45° FOV; color fundus photograph:
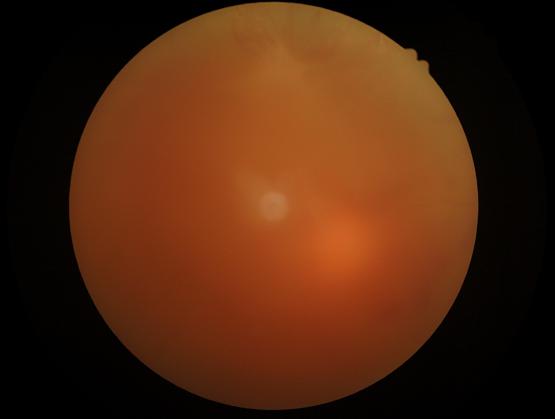

Overall image quality is poor. The image is blurry. Vessels and details are hard to distinguish. There is over- or under-exposure or a color cast.